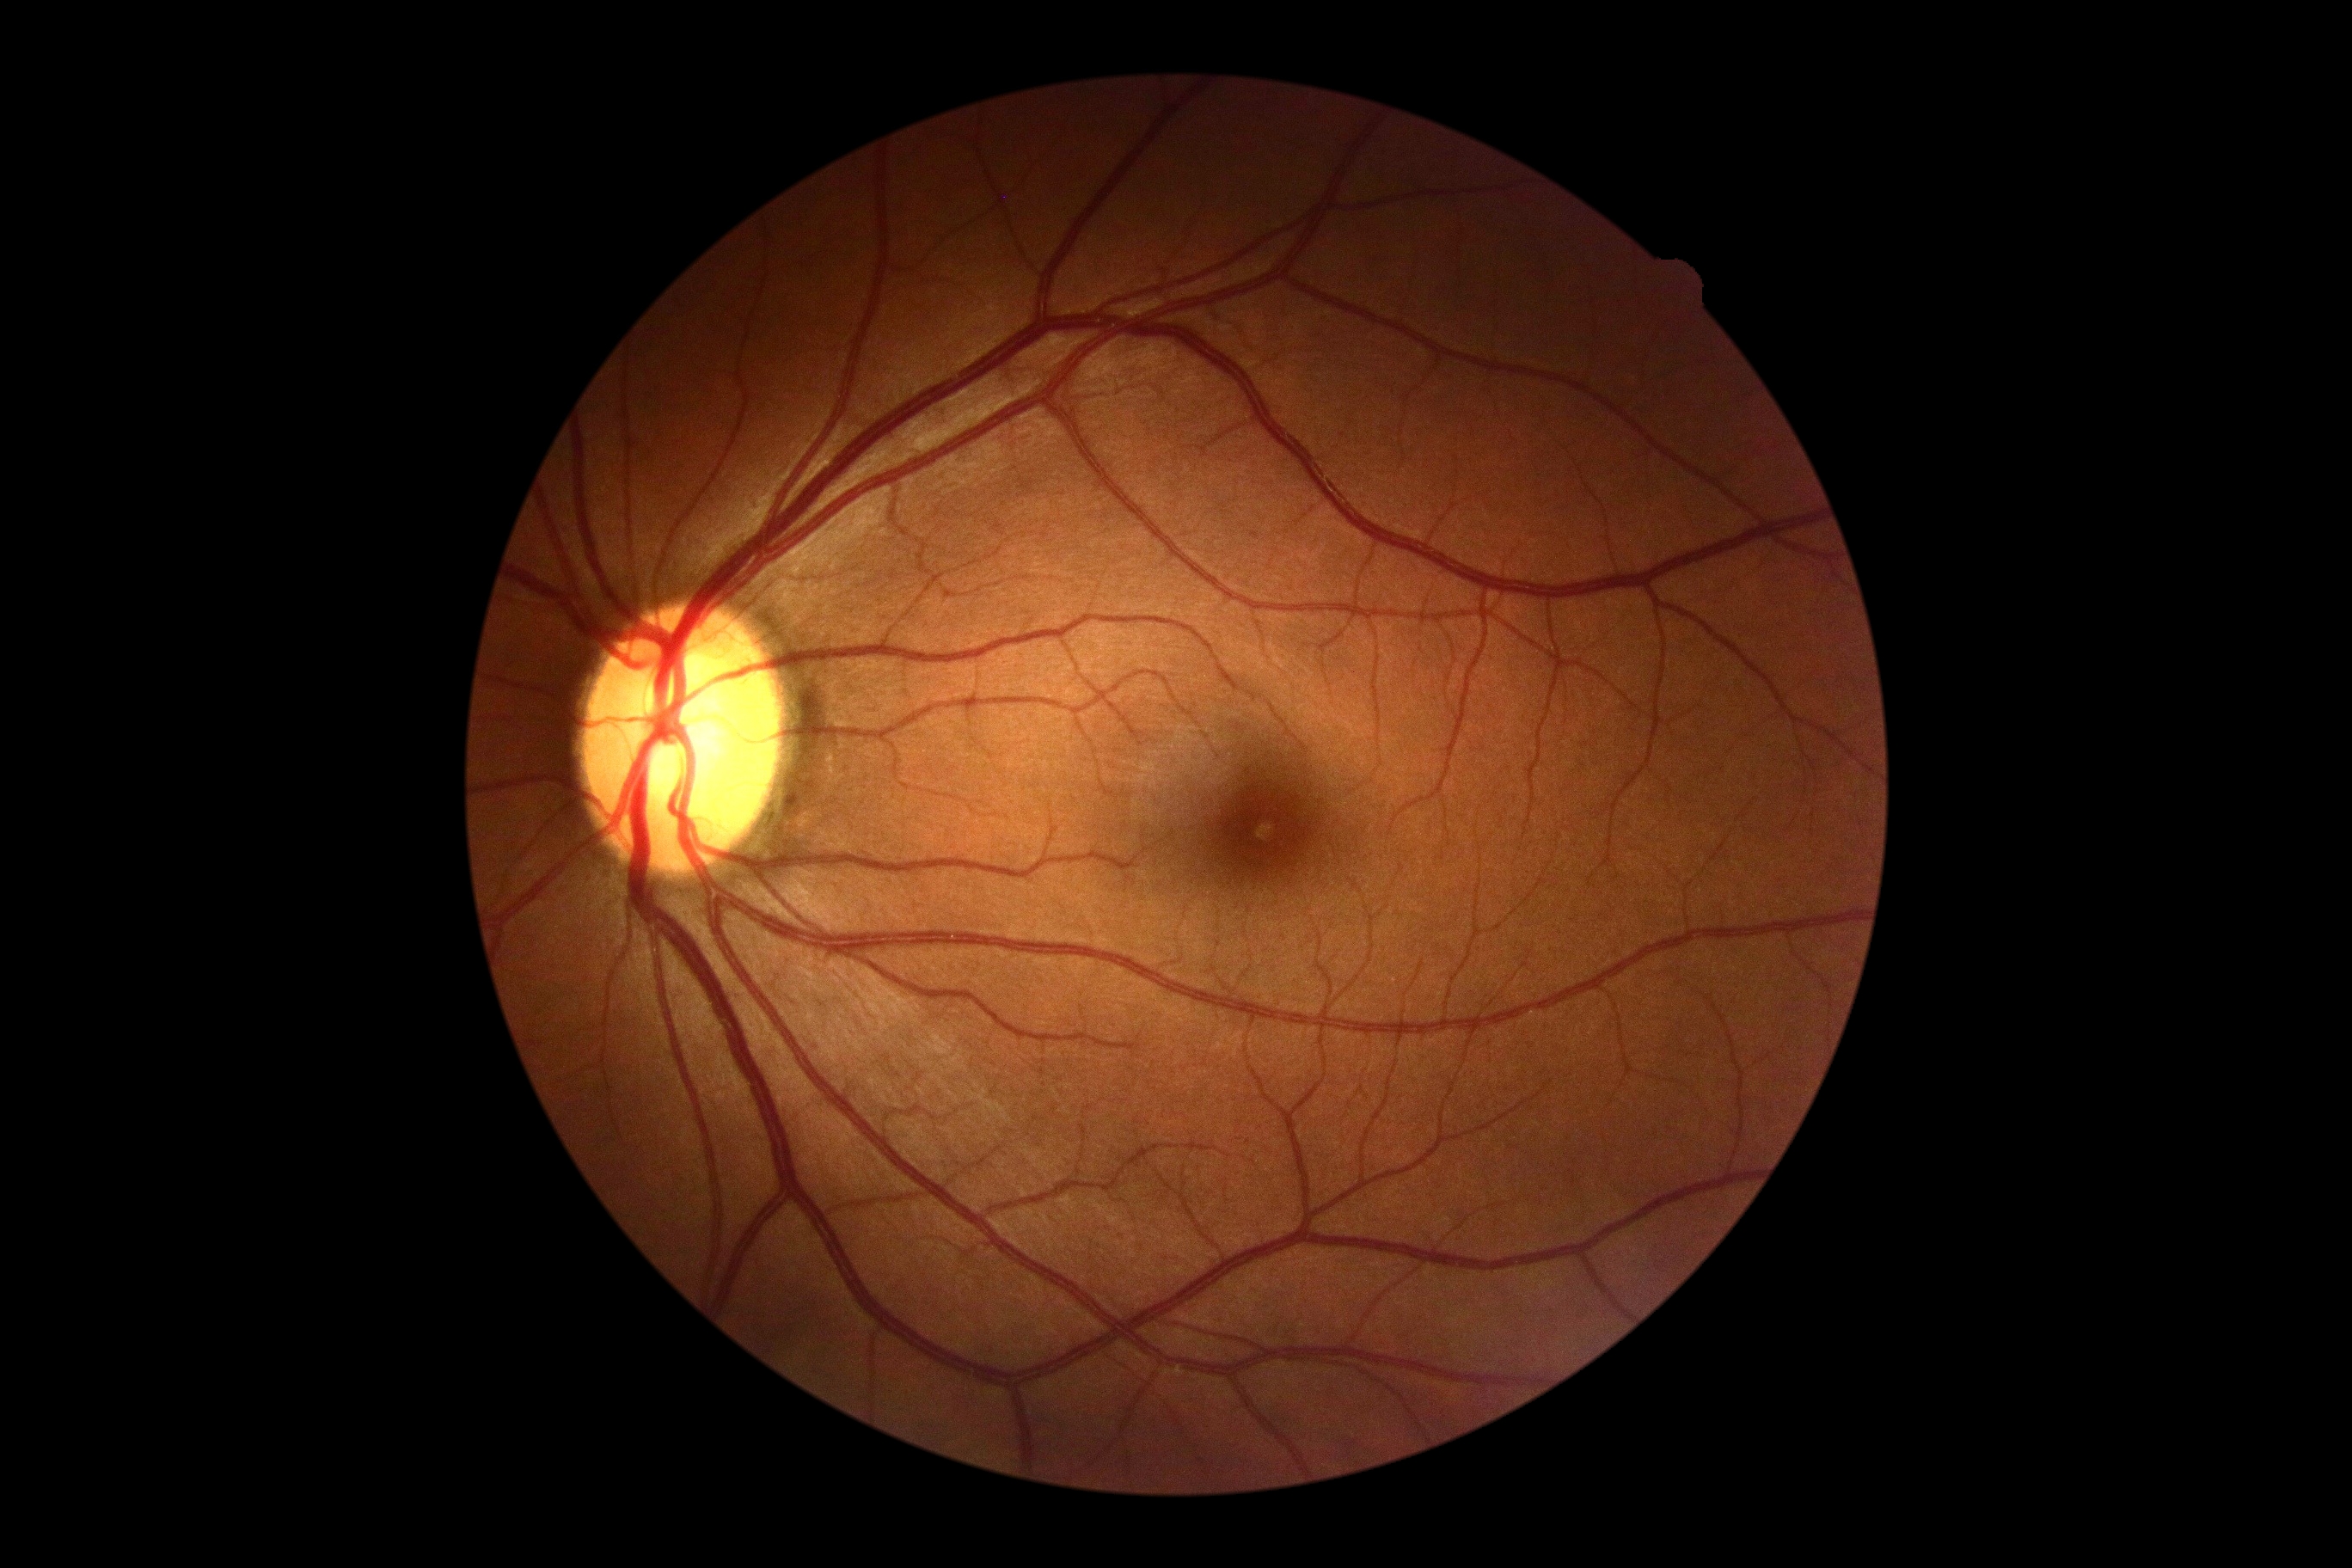
DR is grade 0.